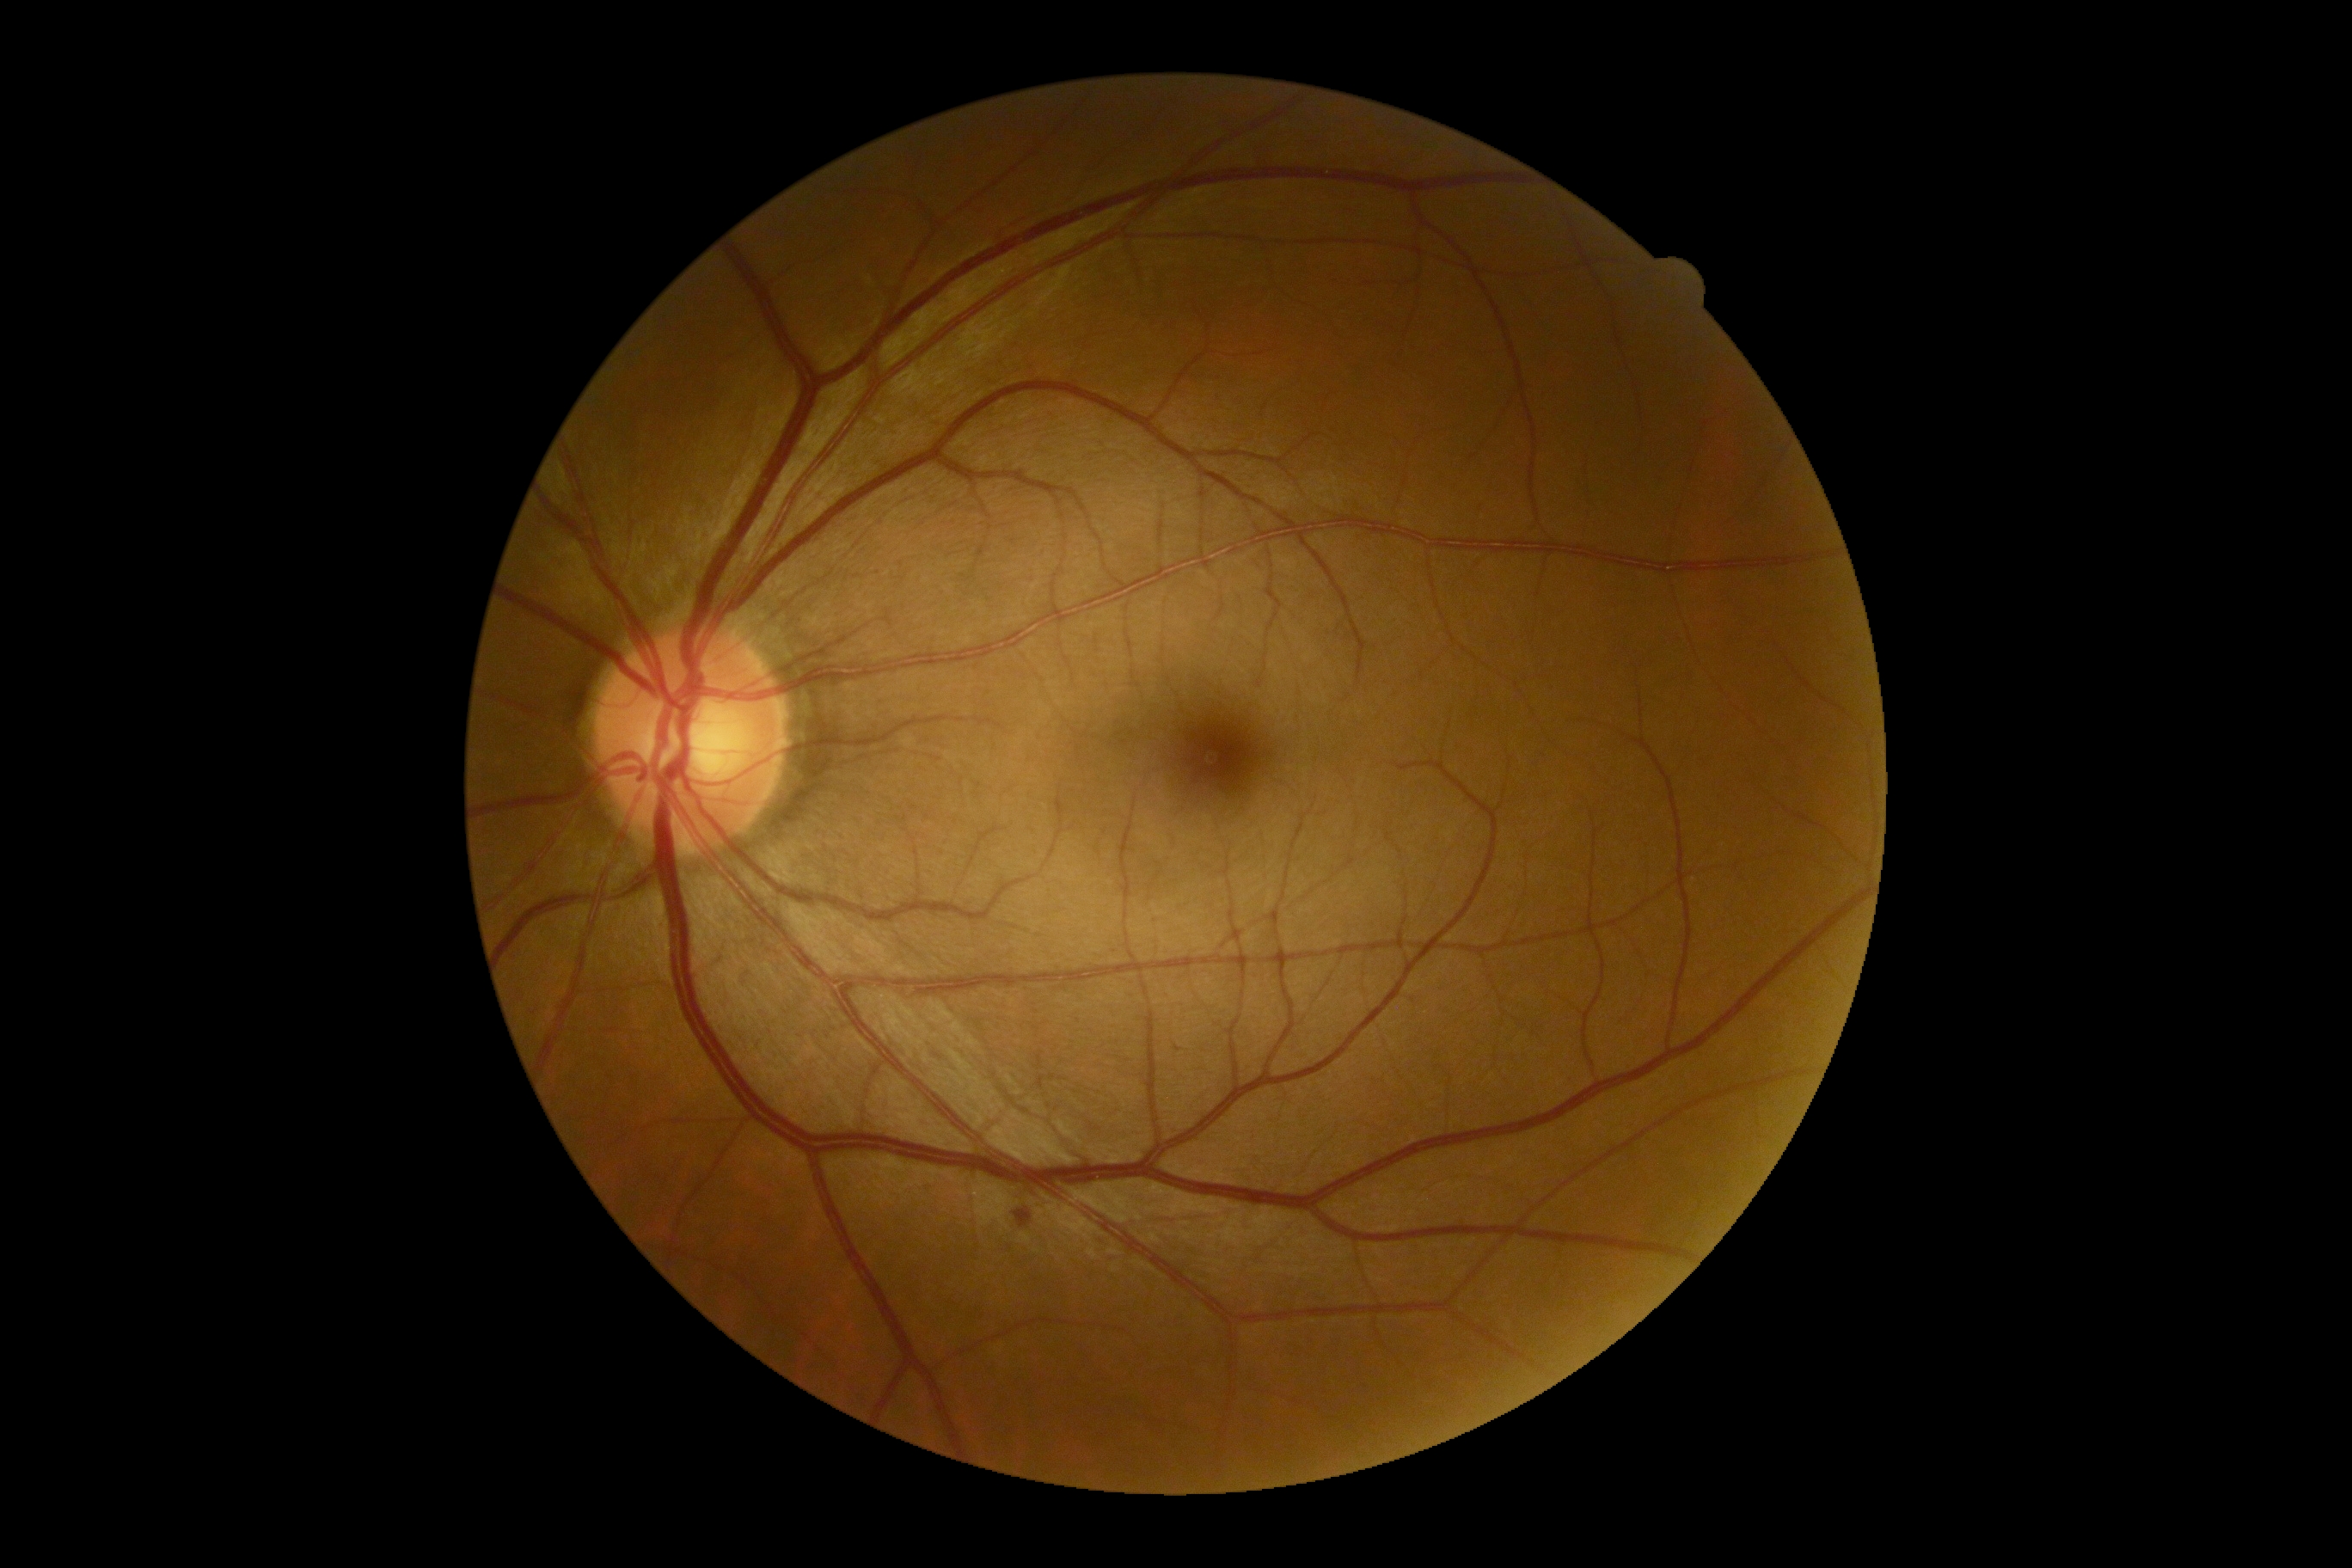

Disease class: non-proliferative diabetic retinopathy. DR severity: moderate NPDR (grade 2) — more than just microaneurysms but less than severe NPDR.